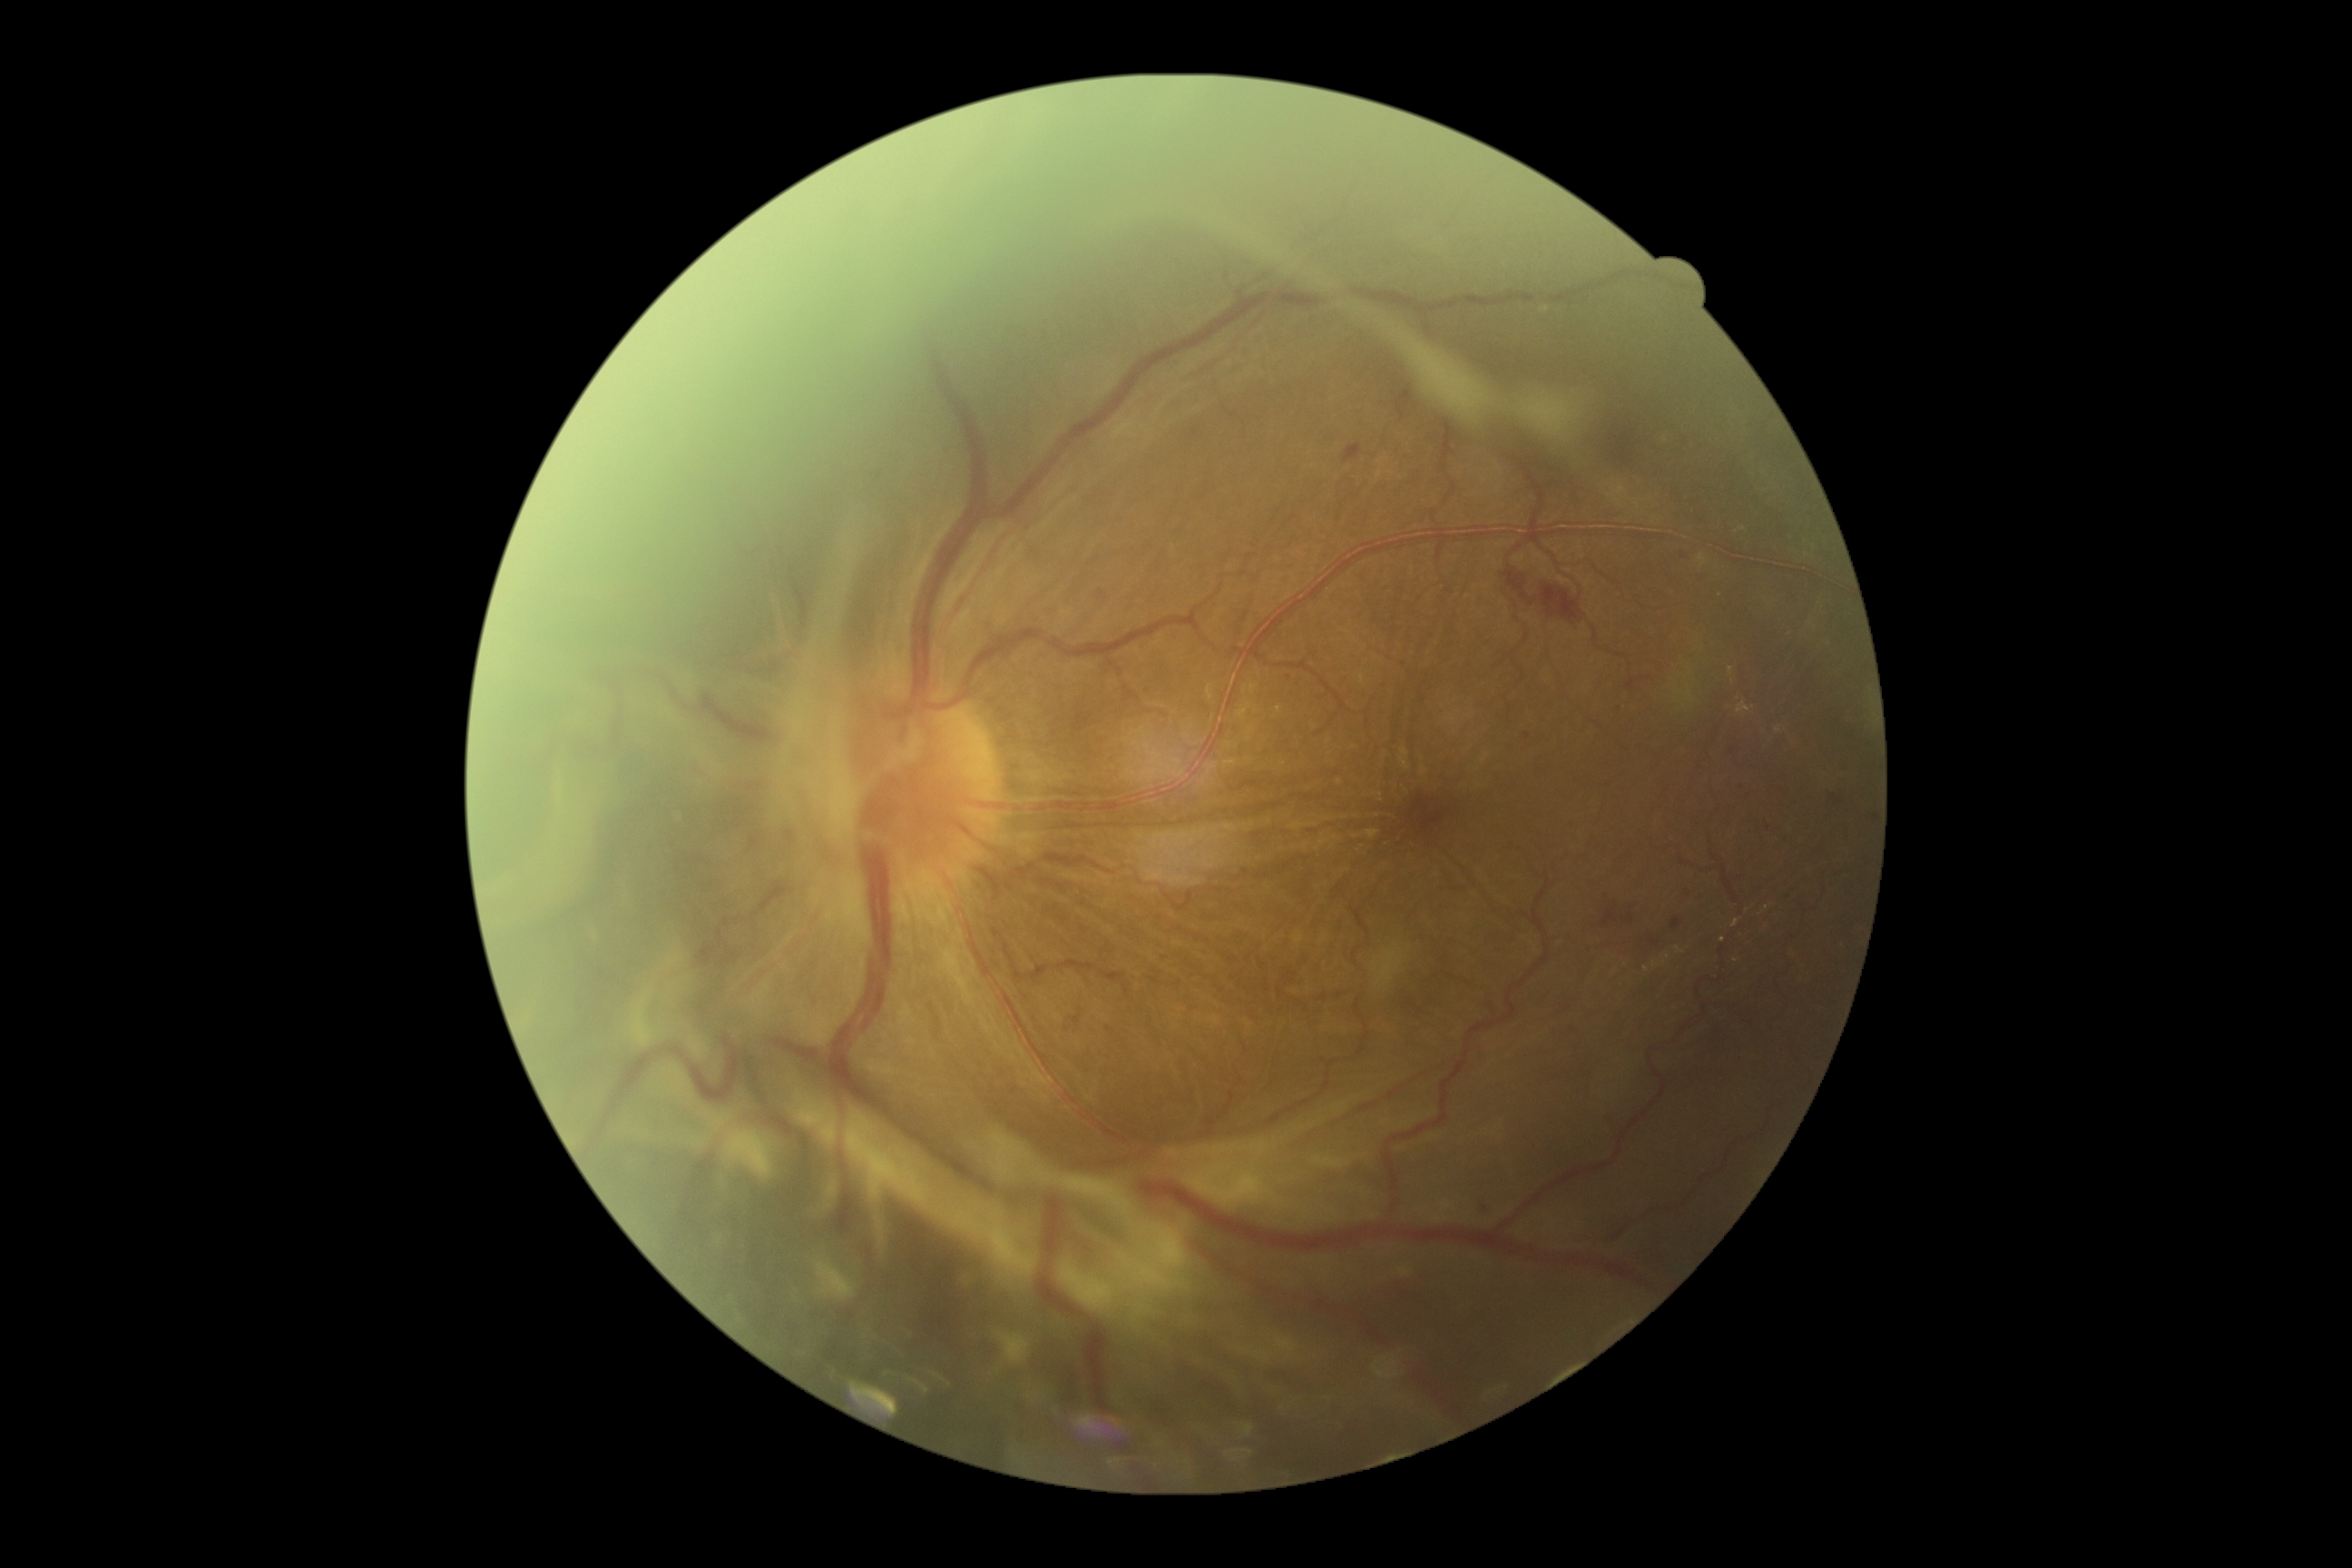 Annotations:
– diabetic retinopathy (DR): 4/4 — neovascularization and/or vitreous/pre-retinal hemorrhage